Retinal fundus photograph; 45° FOV; 2048 x 1536 pixels
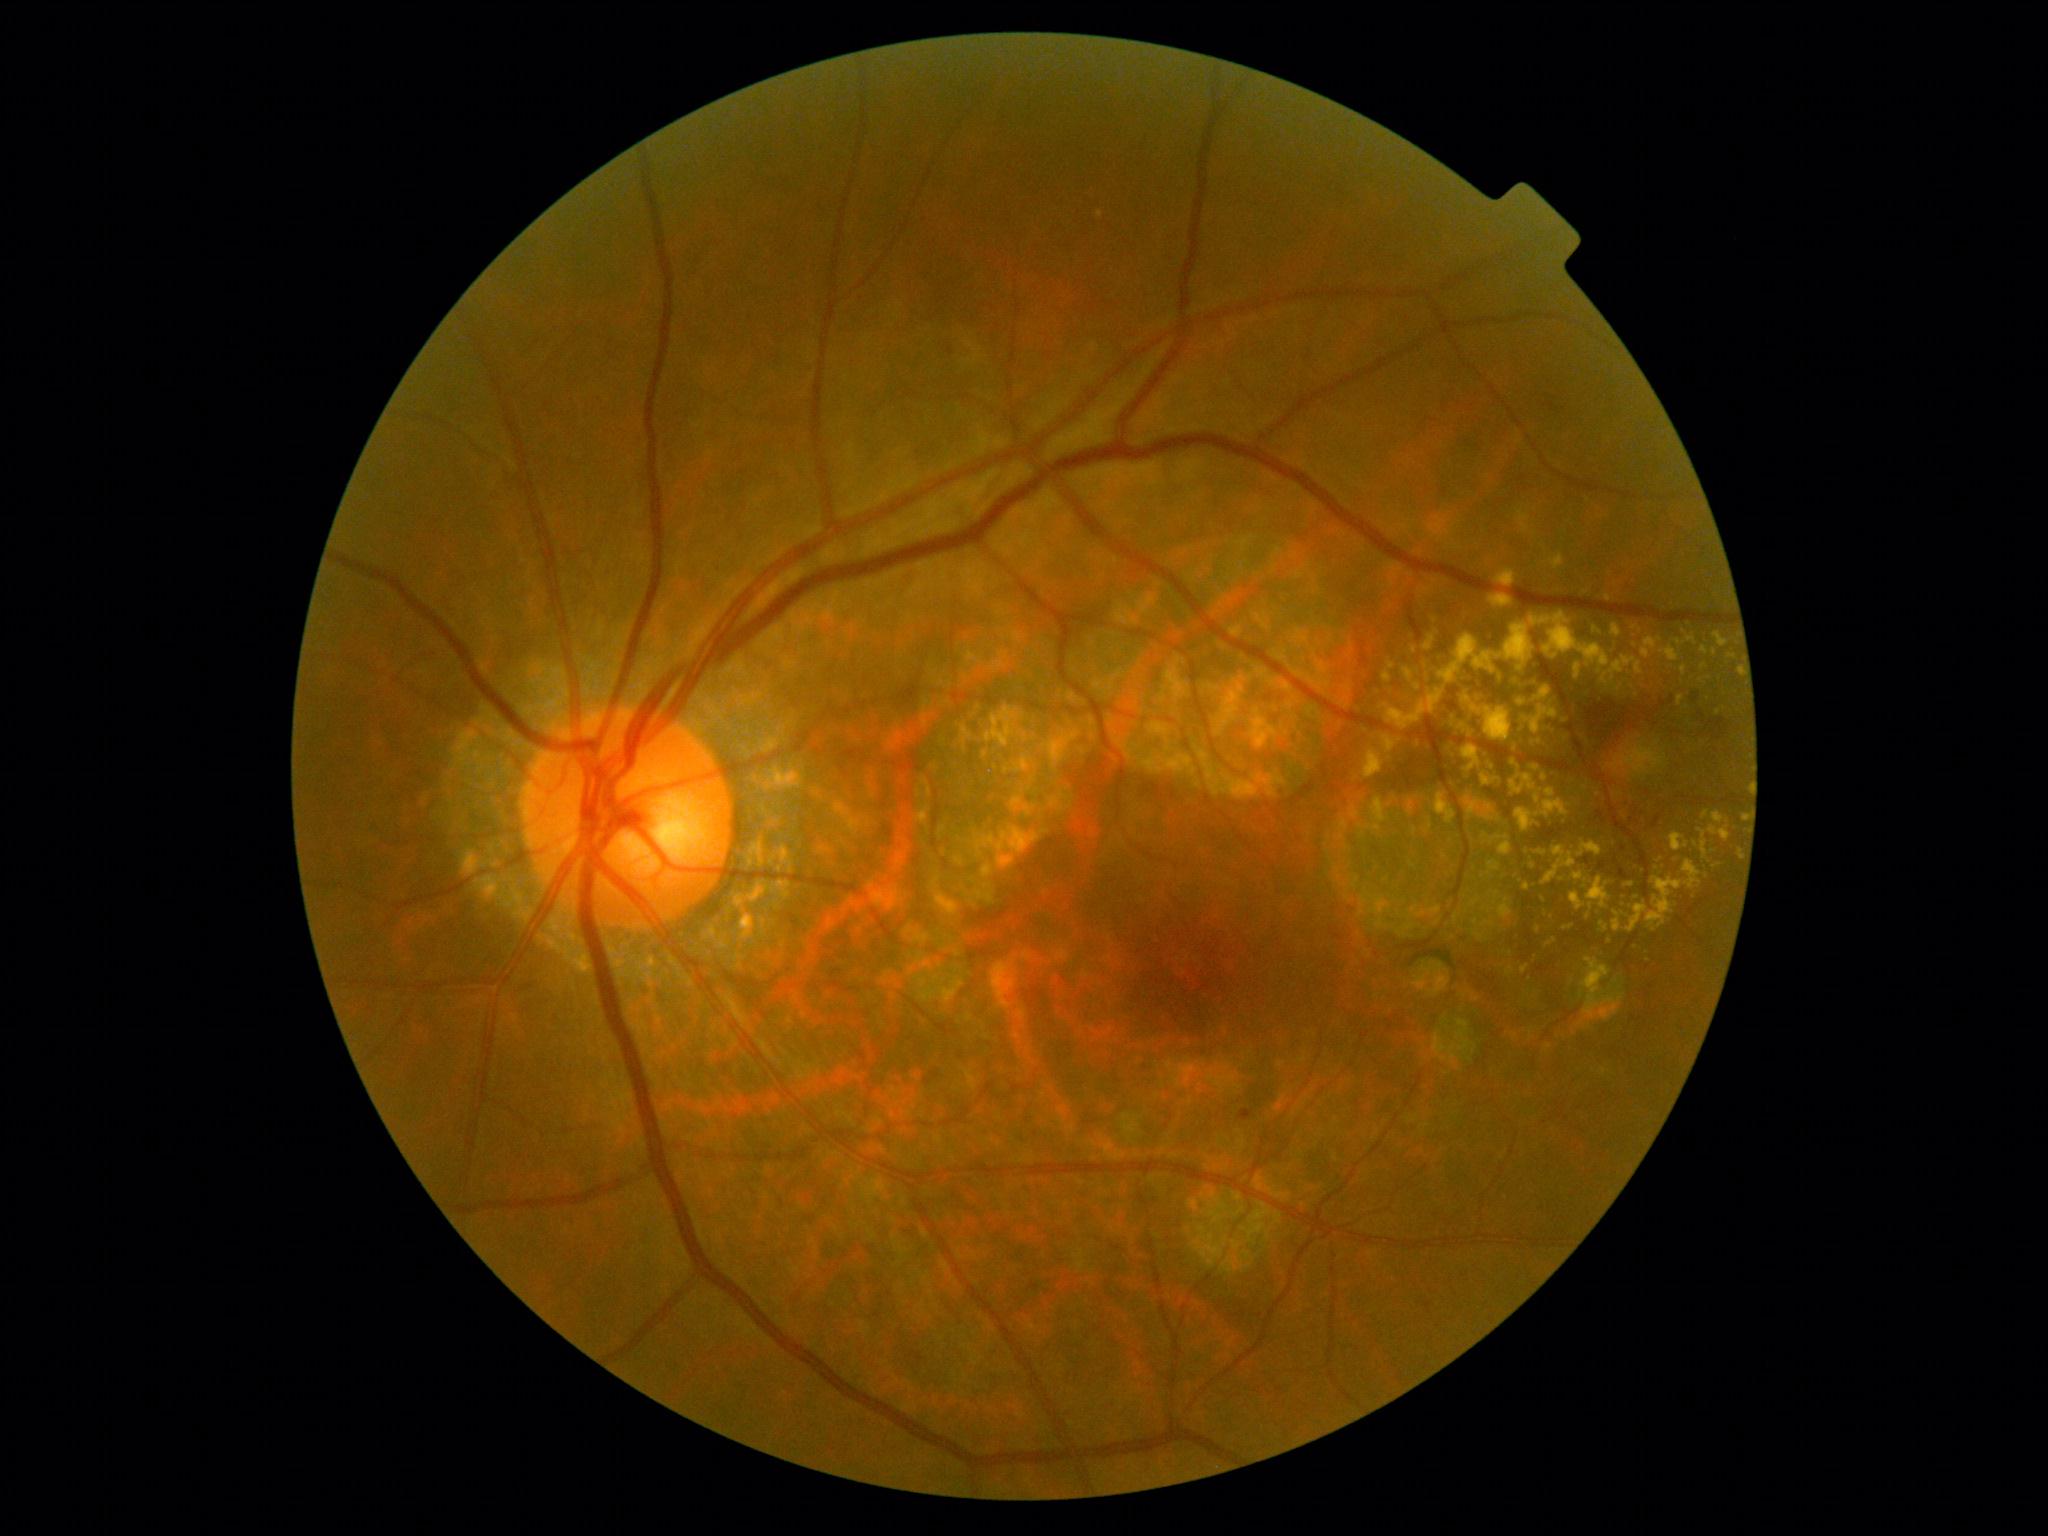
Diabetic retinopathy (DR) is 2/4 — more than just microaneurysms but less than severe NPDR; non-proliferative diabetic retinopathy
Lesions identified (partial list):
- hard exudates (EXs) (continued): bbox=[1601, 656, 1644, 686]; bbox=[1738, 667, 1743, 676]; bbox=[1487, 861, 1500, 875]; bbox=[1479, 803, 1502, 822]; bbox=[1383, 661, 1396, 683]; bbox=[1529, 613, 1611, 674]; bbox=[1701, 647, 1708, 656]; bbox=[1575, 664, 1582, 680]; bbox=[1414, 683, 1421, 691]; bbox=[1660, 646, 1680, 663]; bbox=[1364, 749, 1384, 779]; bbox=[1678, 696, 1685, 707]; bbox=[1466, 706, 1480, 725]
- Small EXs approximately at point(1636, 898); point(1485, 837); point(1636, 646); point(1533, 866); point(1657, 868); point(1538, 930); point(1719, 865)